Color fundus image:
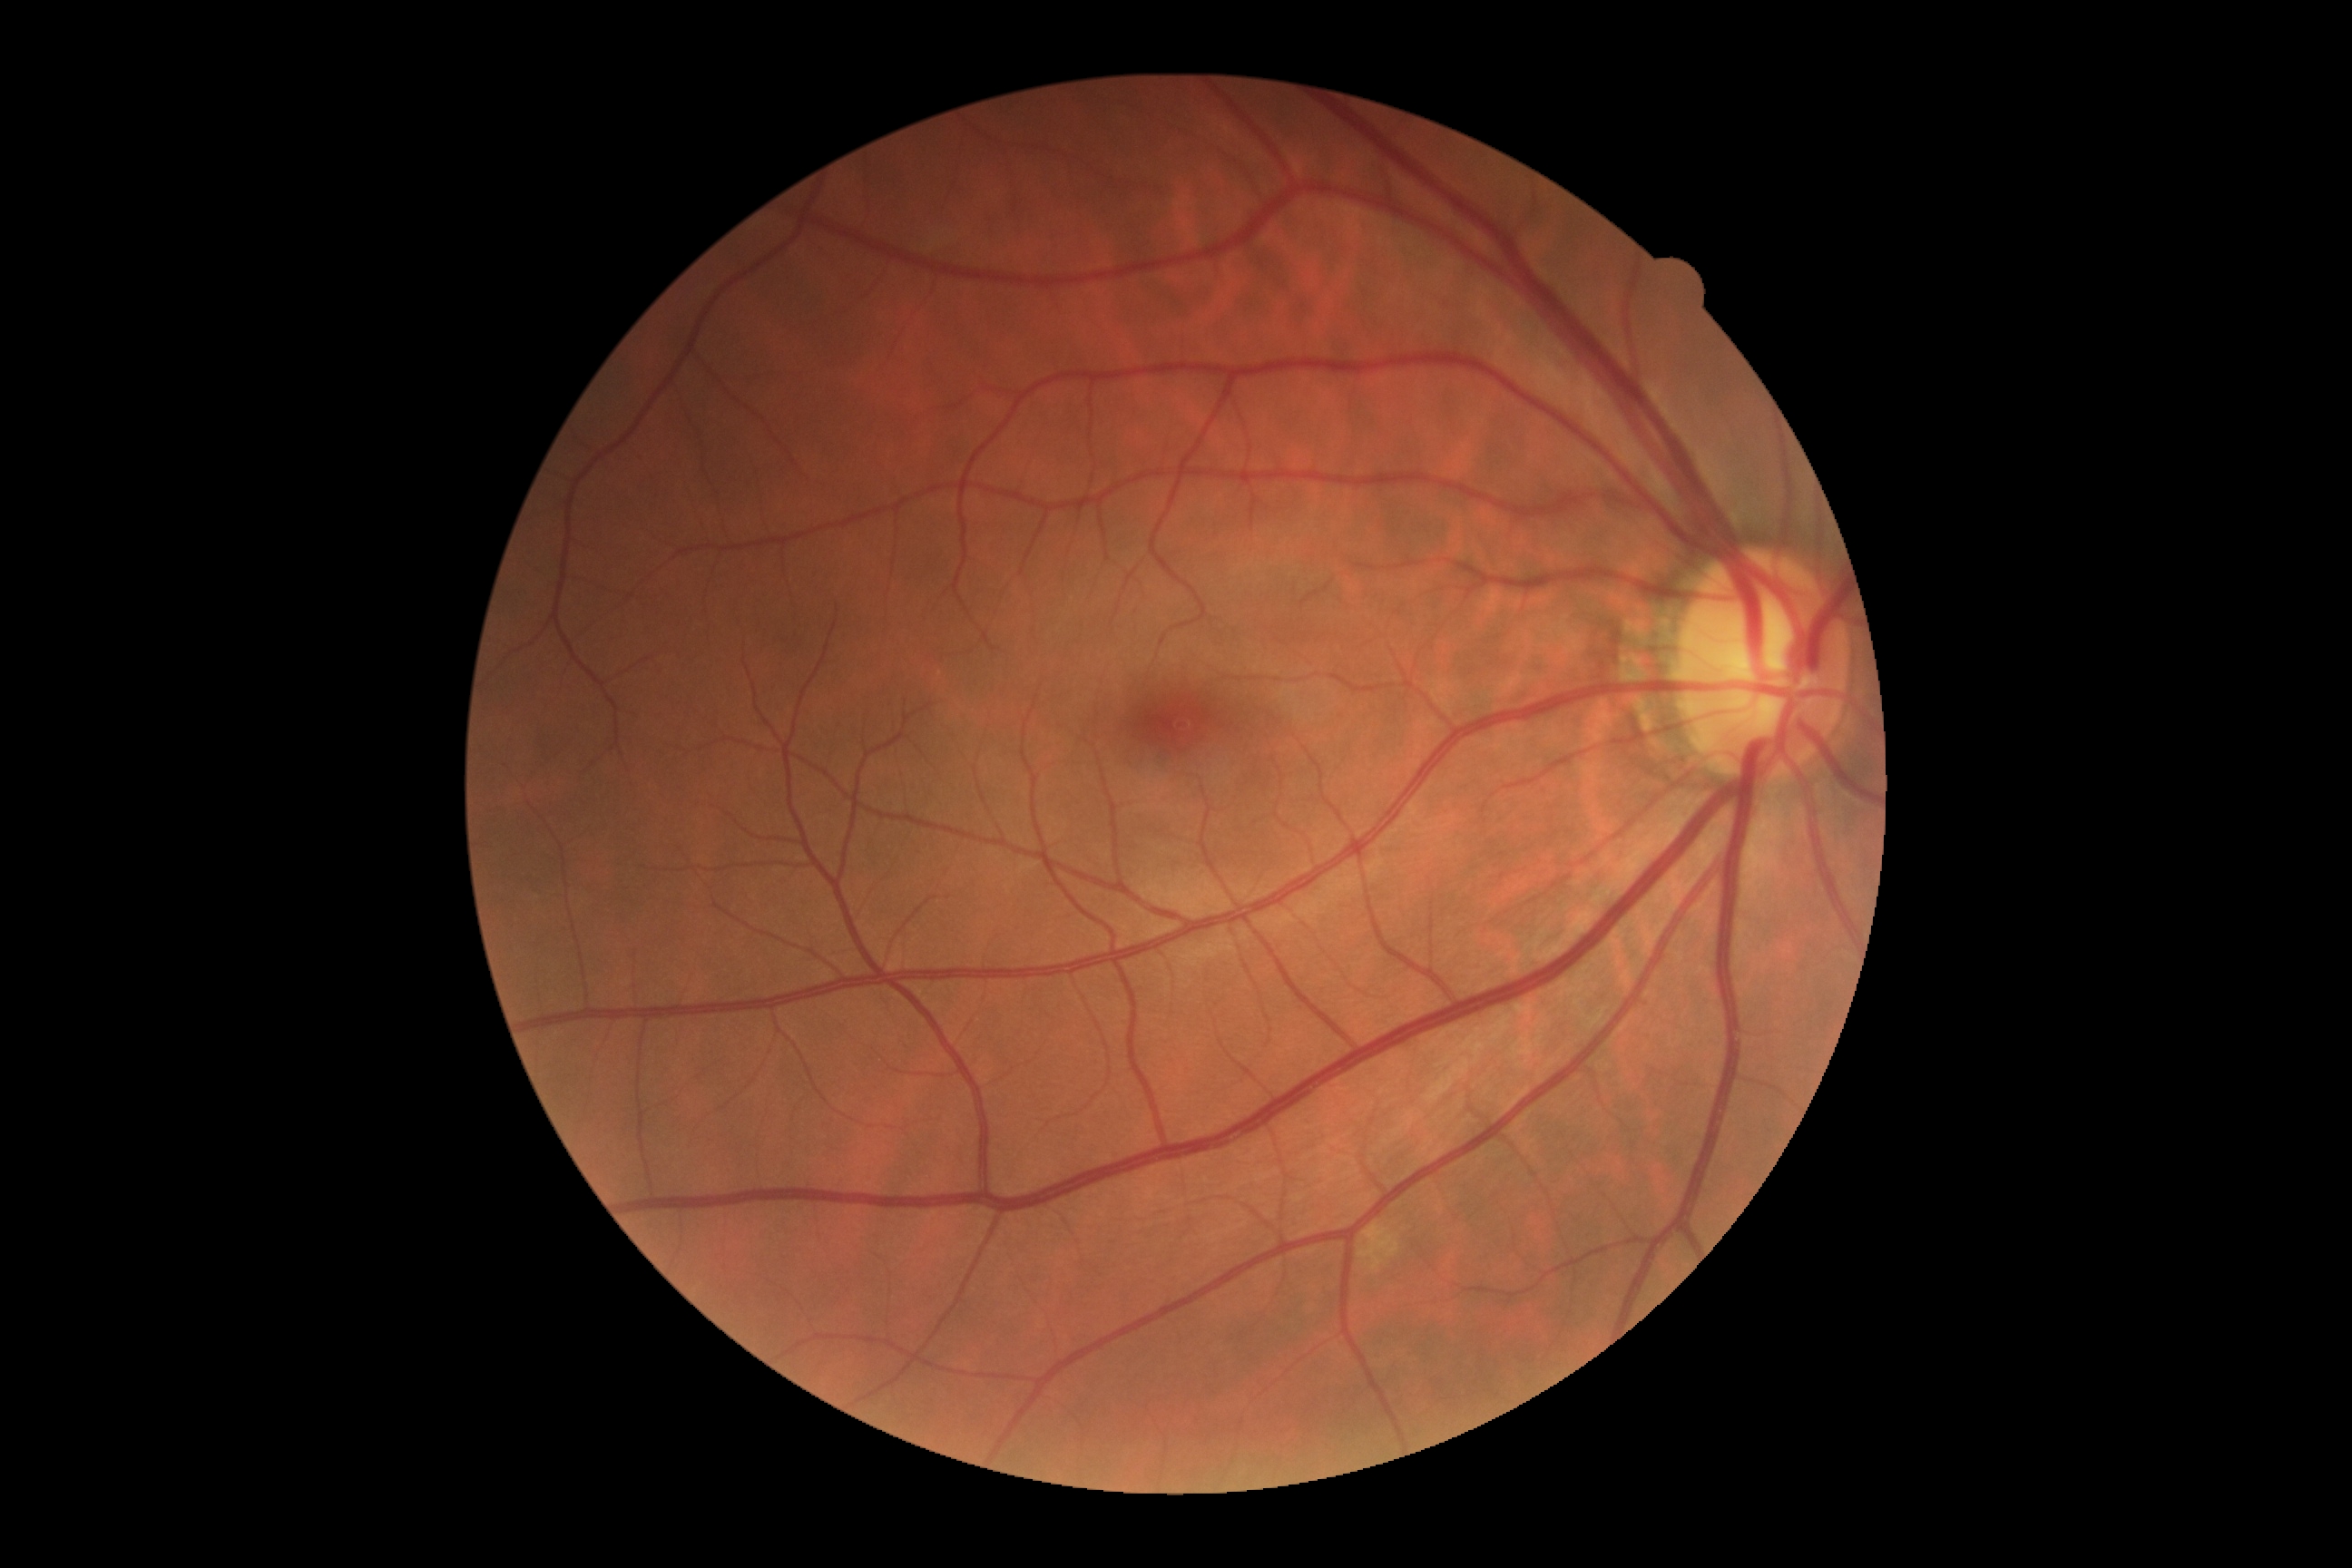

DR impression: negative for DR; DR stage: no apparent diabetic retinopathy (grade 0).